2048x1536
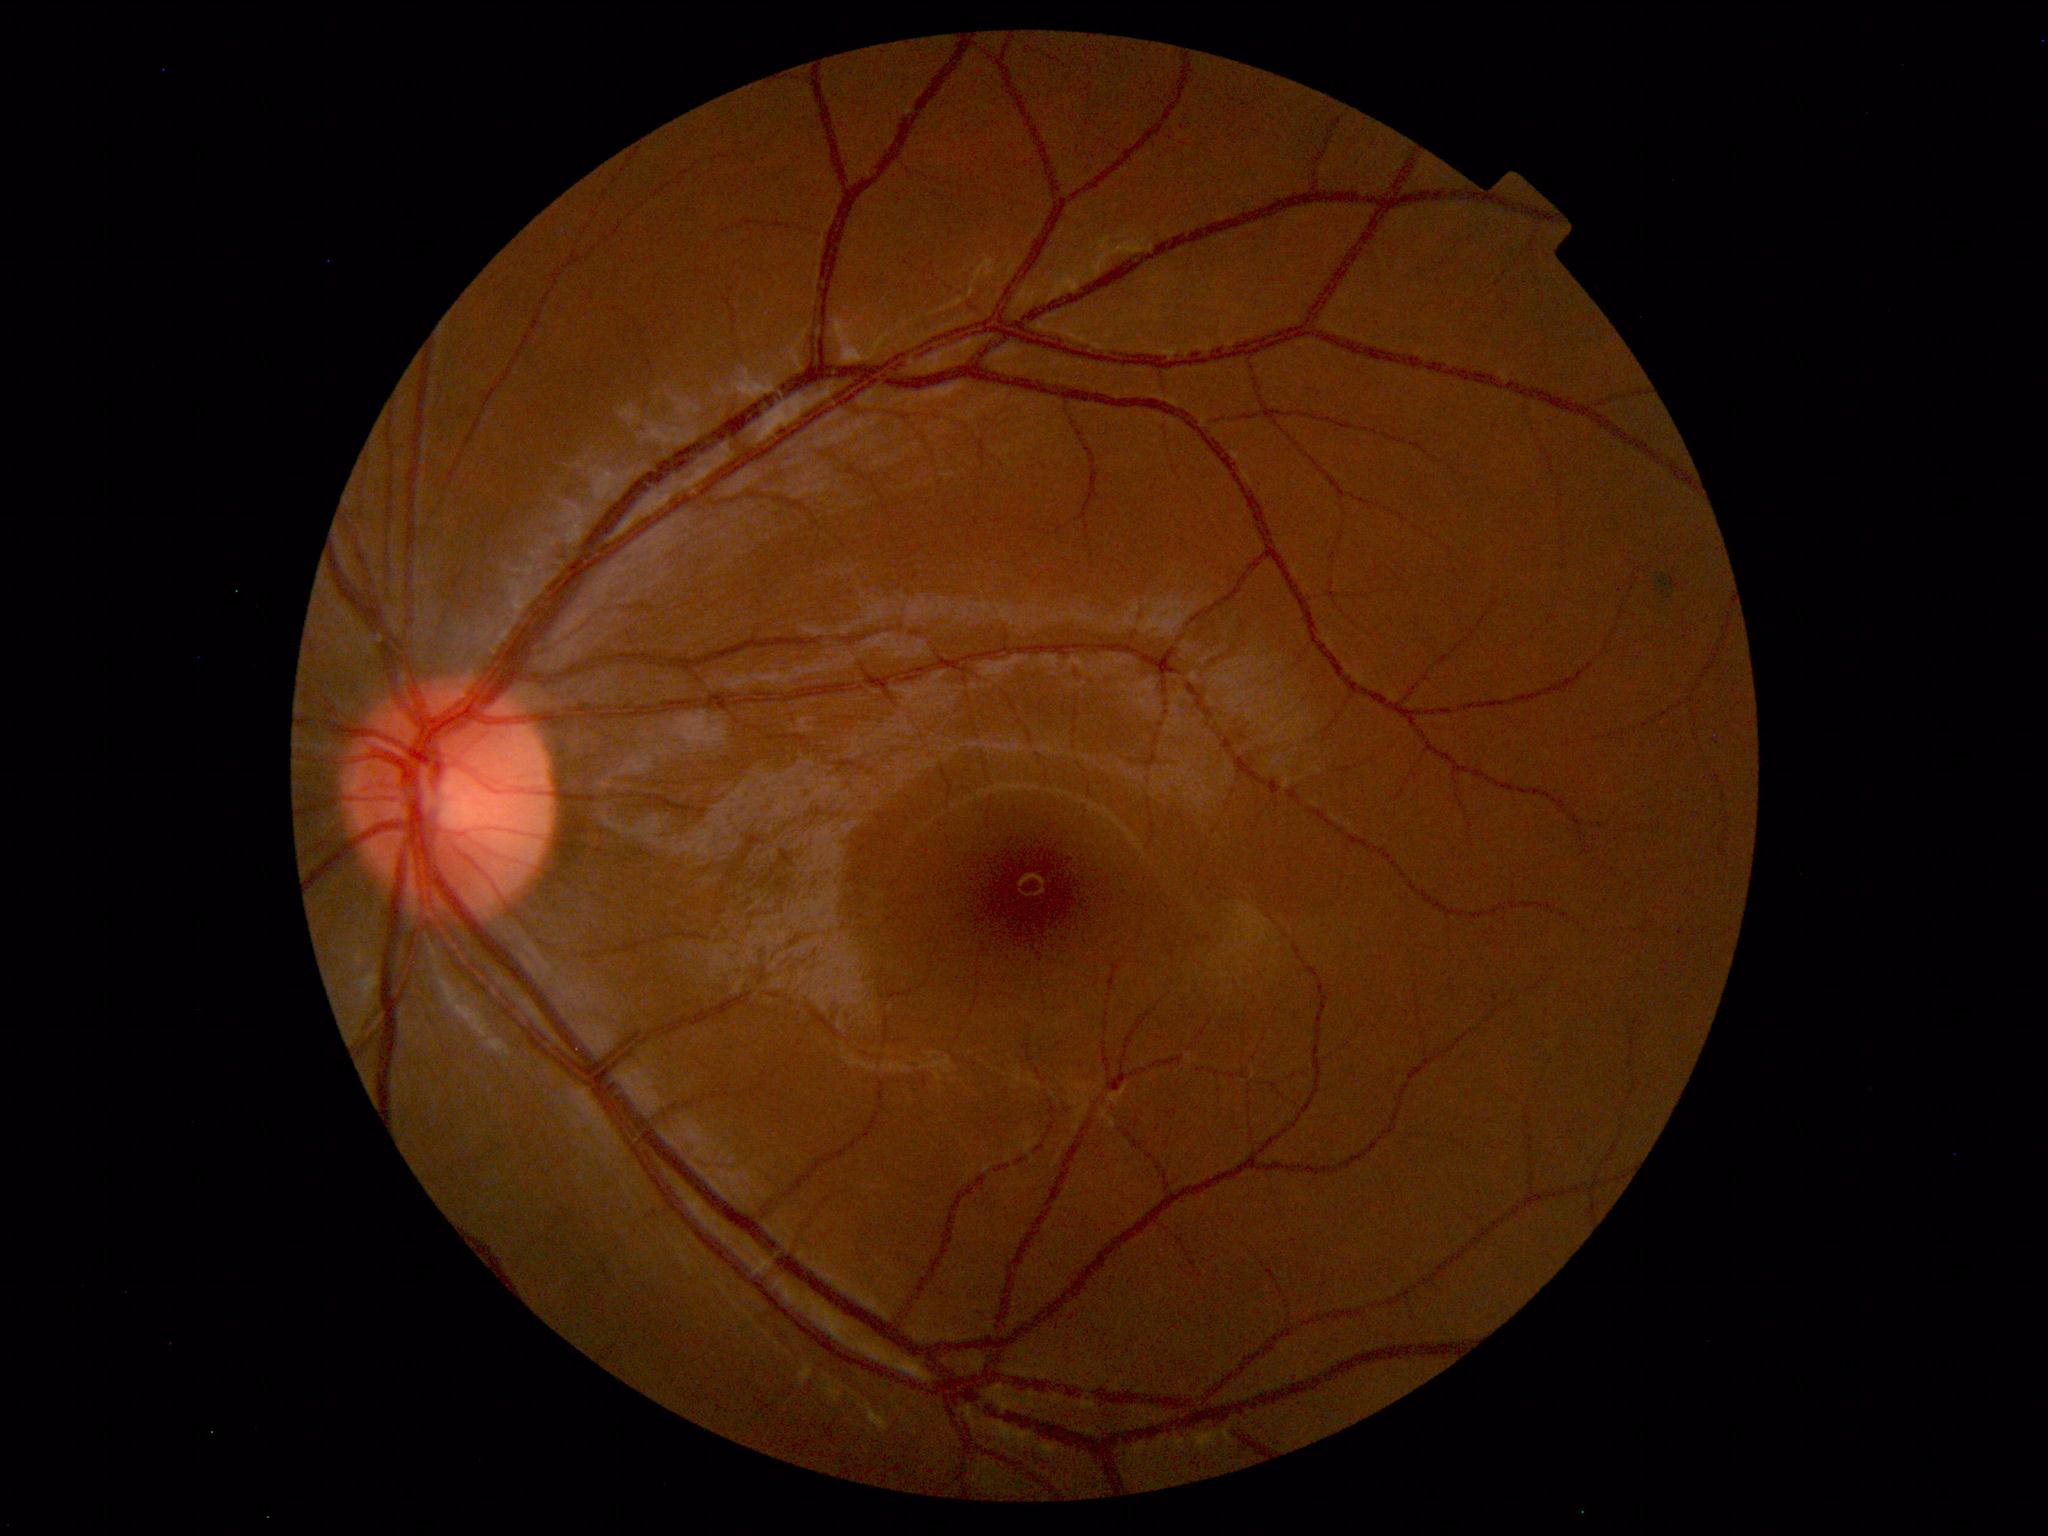
The fundus appears normal with no pathological findings.